Modified Davis classification.
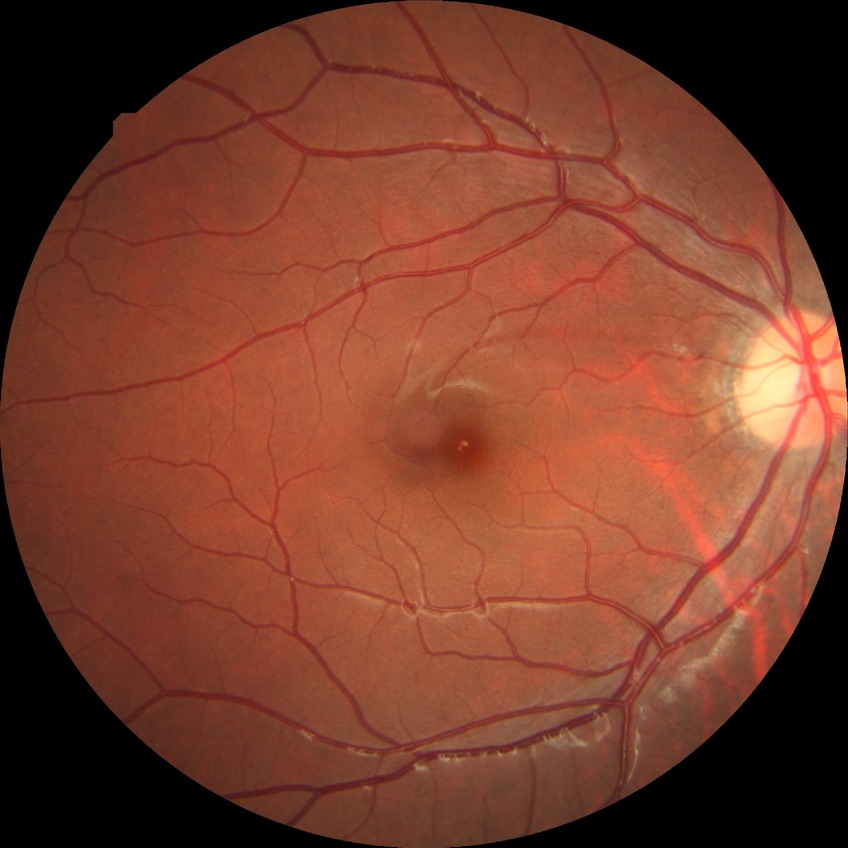
retinopathy grade = no diabetic retinopathy